Nonmydriatic, Davis DR grading, image size 848x848, camera: NIDEK AFC-230: 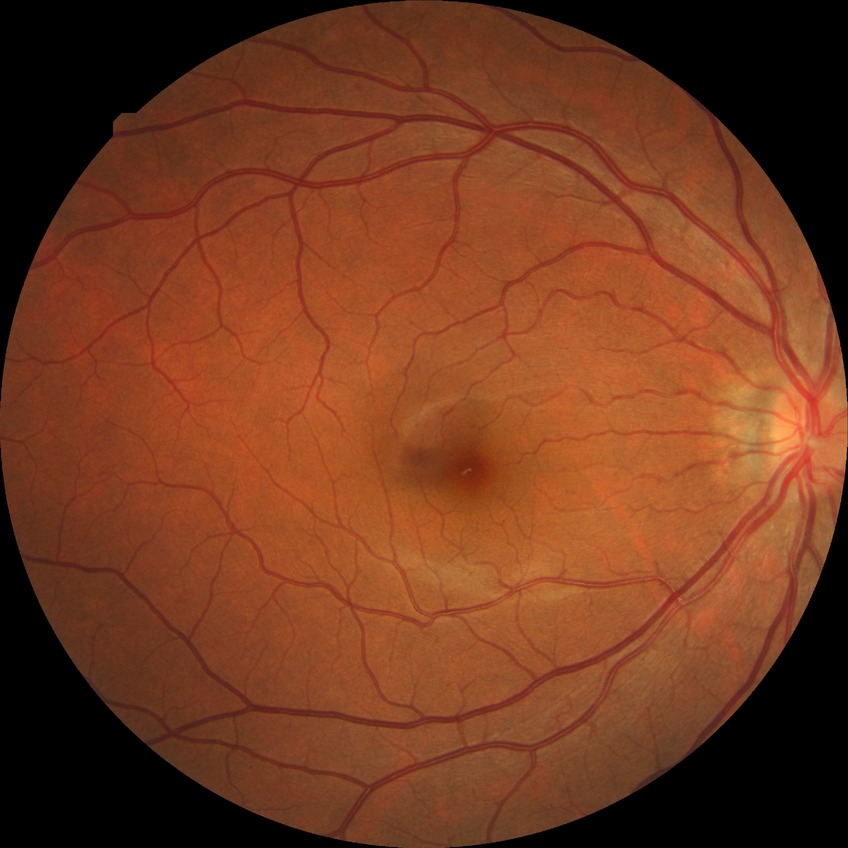 Davis grading is no diabetic retinopathy.